Phoenix ICON wide-field infant fundus image; 100° field of view (Phoenix ICON):
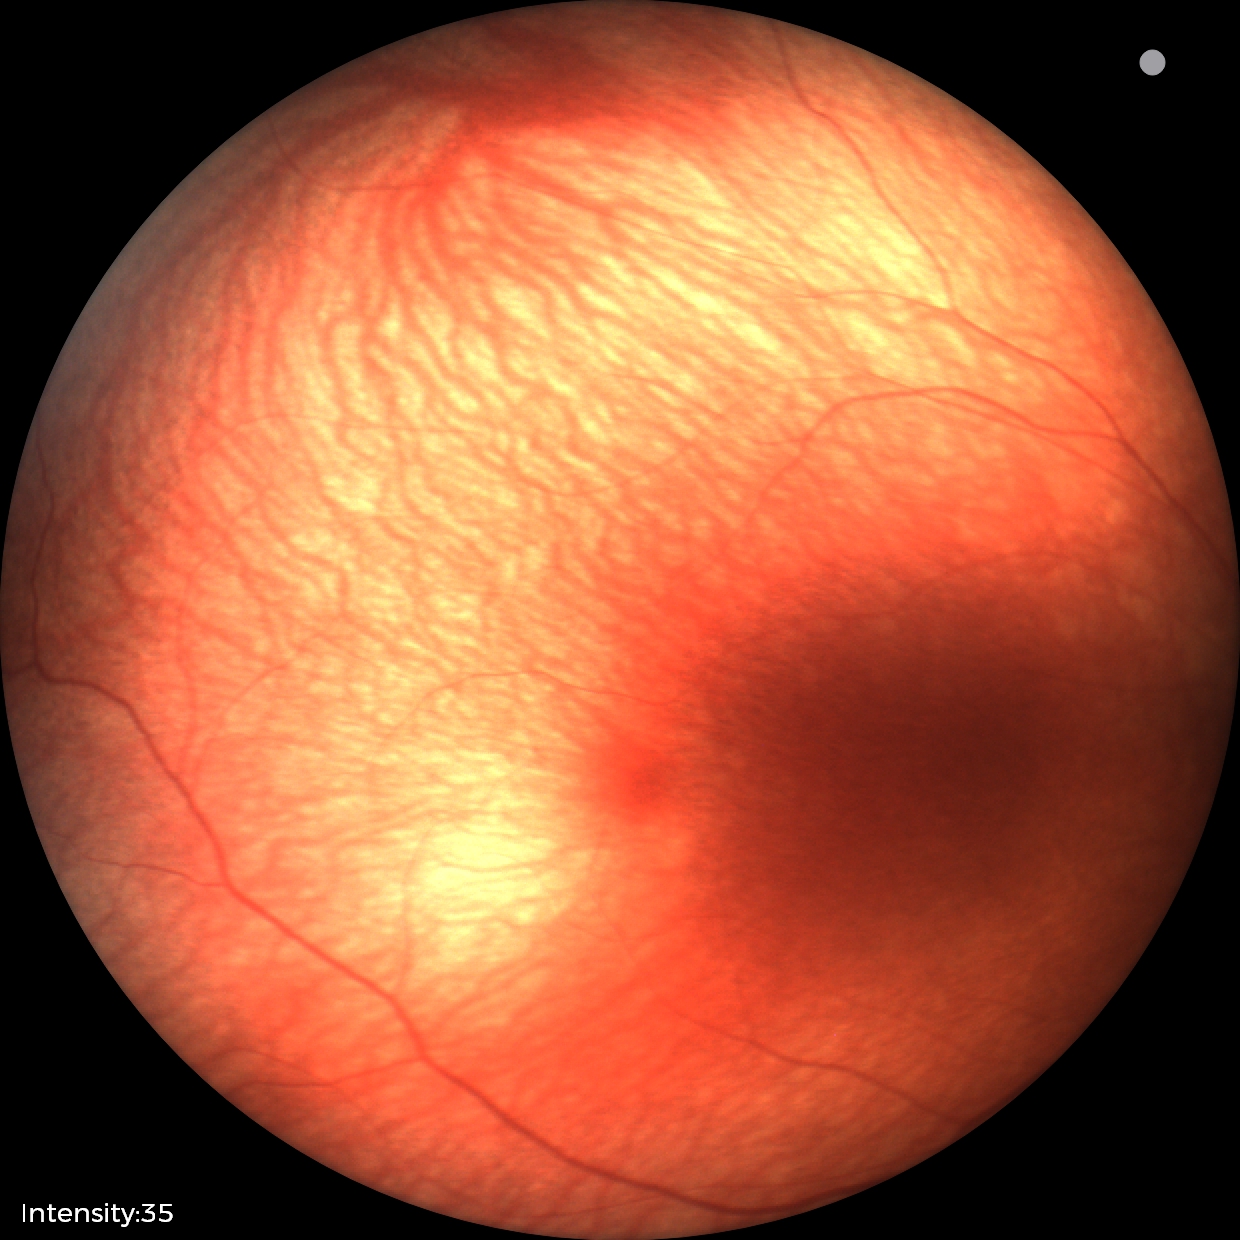 Normal screening examination.